Refraction: -1.25 -0.5 x 150 · optic disc-centered · age 41 · axial length 22.8 mm · central corneal thickness: 605 µm · intraocular pressure (IOP) 13 mmHg · Topcon TRC-NW400
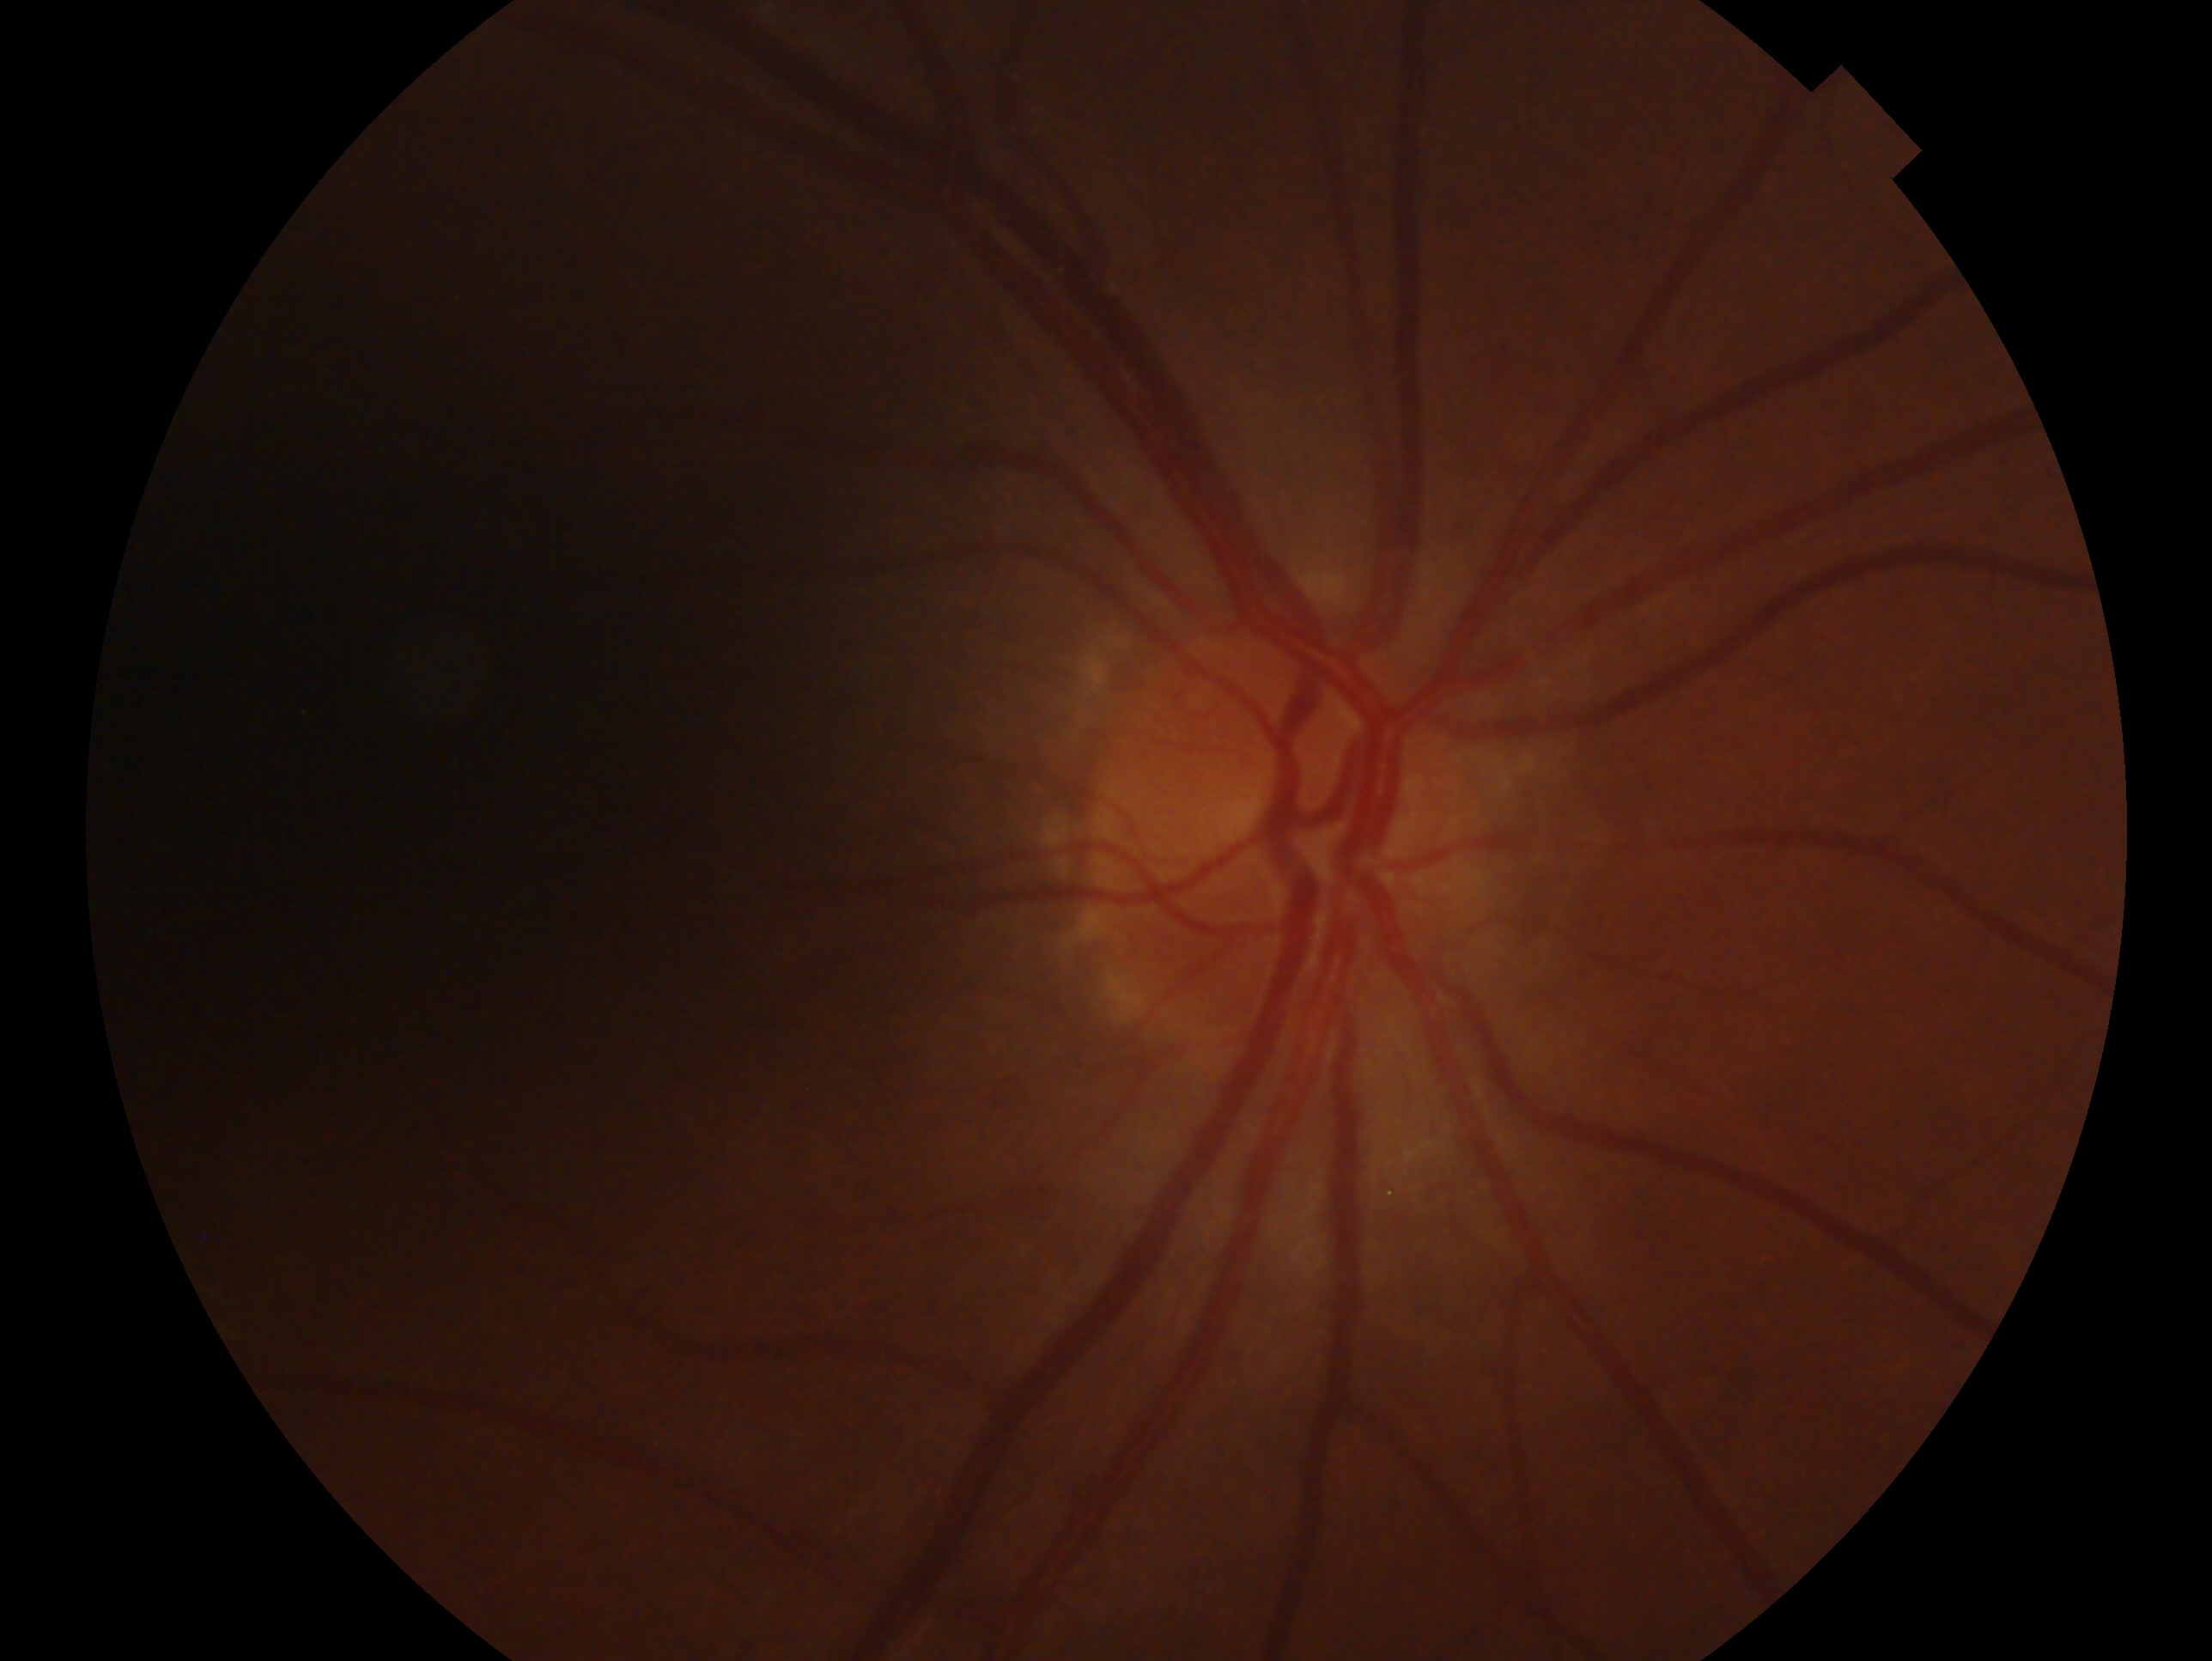

Q: Glaucoma classification?
A: no glaucomatous findings
Q: Which eye is imaged?
A: right eye